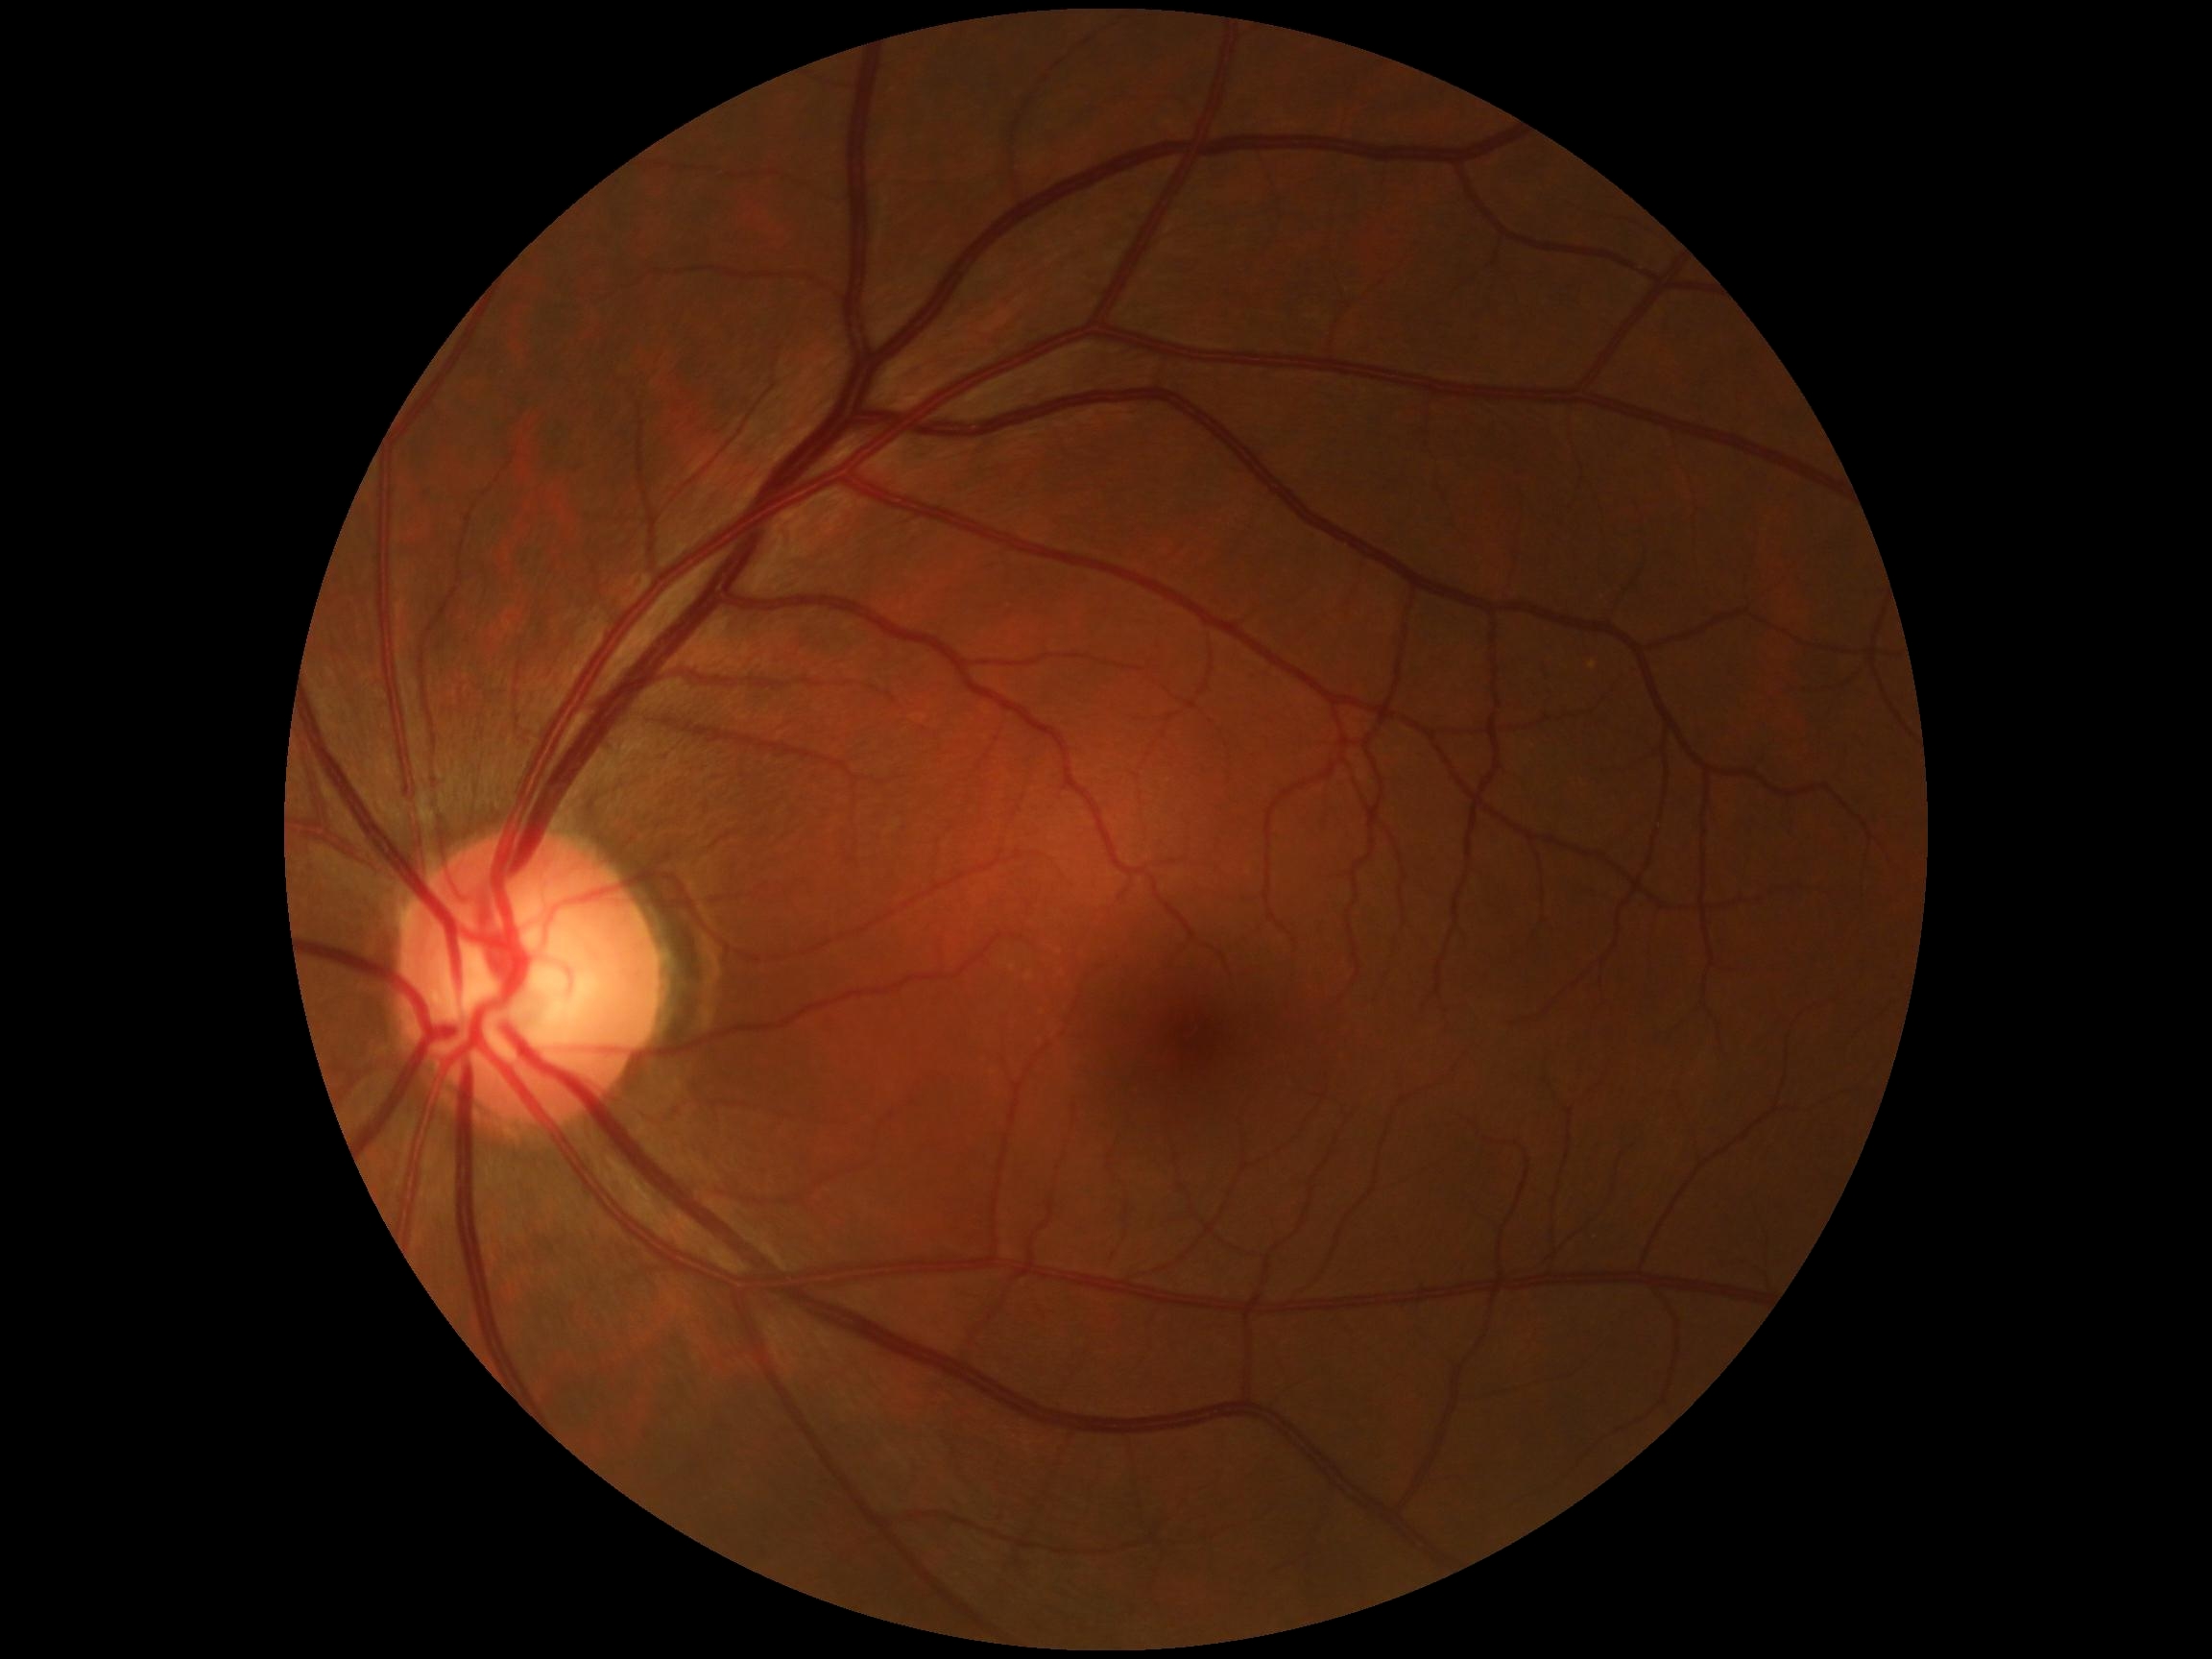
DR grade is 0 (no apparent retinopathy).